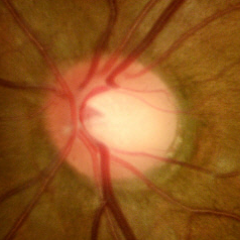

Fundus appearance consistent with no glaucoma.